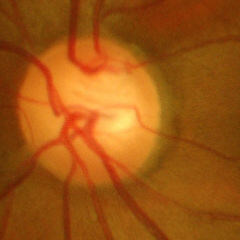 Glaucoma assessment: advanced-stage glaucoma. Defined as near-total cupping of the optic nerve head, with or without severe visual field loss within the central 10 degrees of fixation.